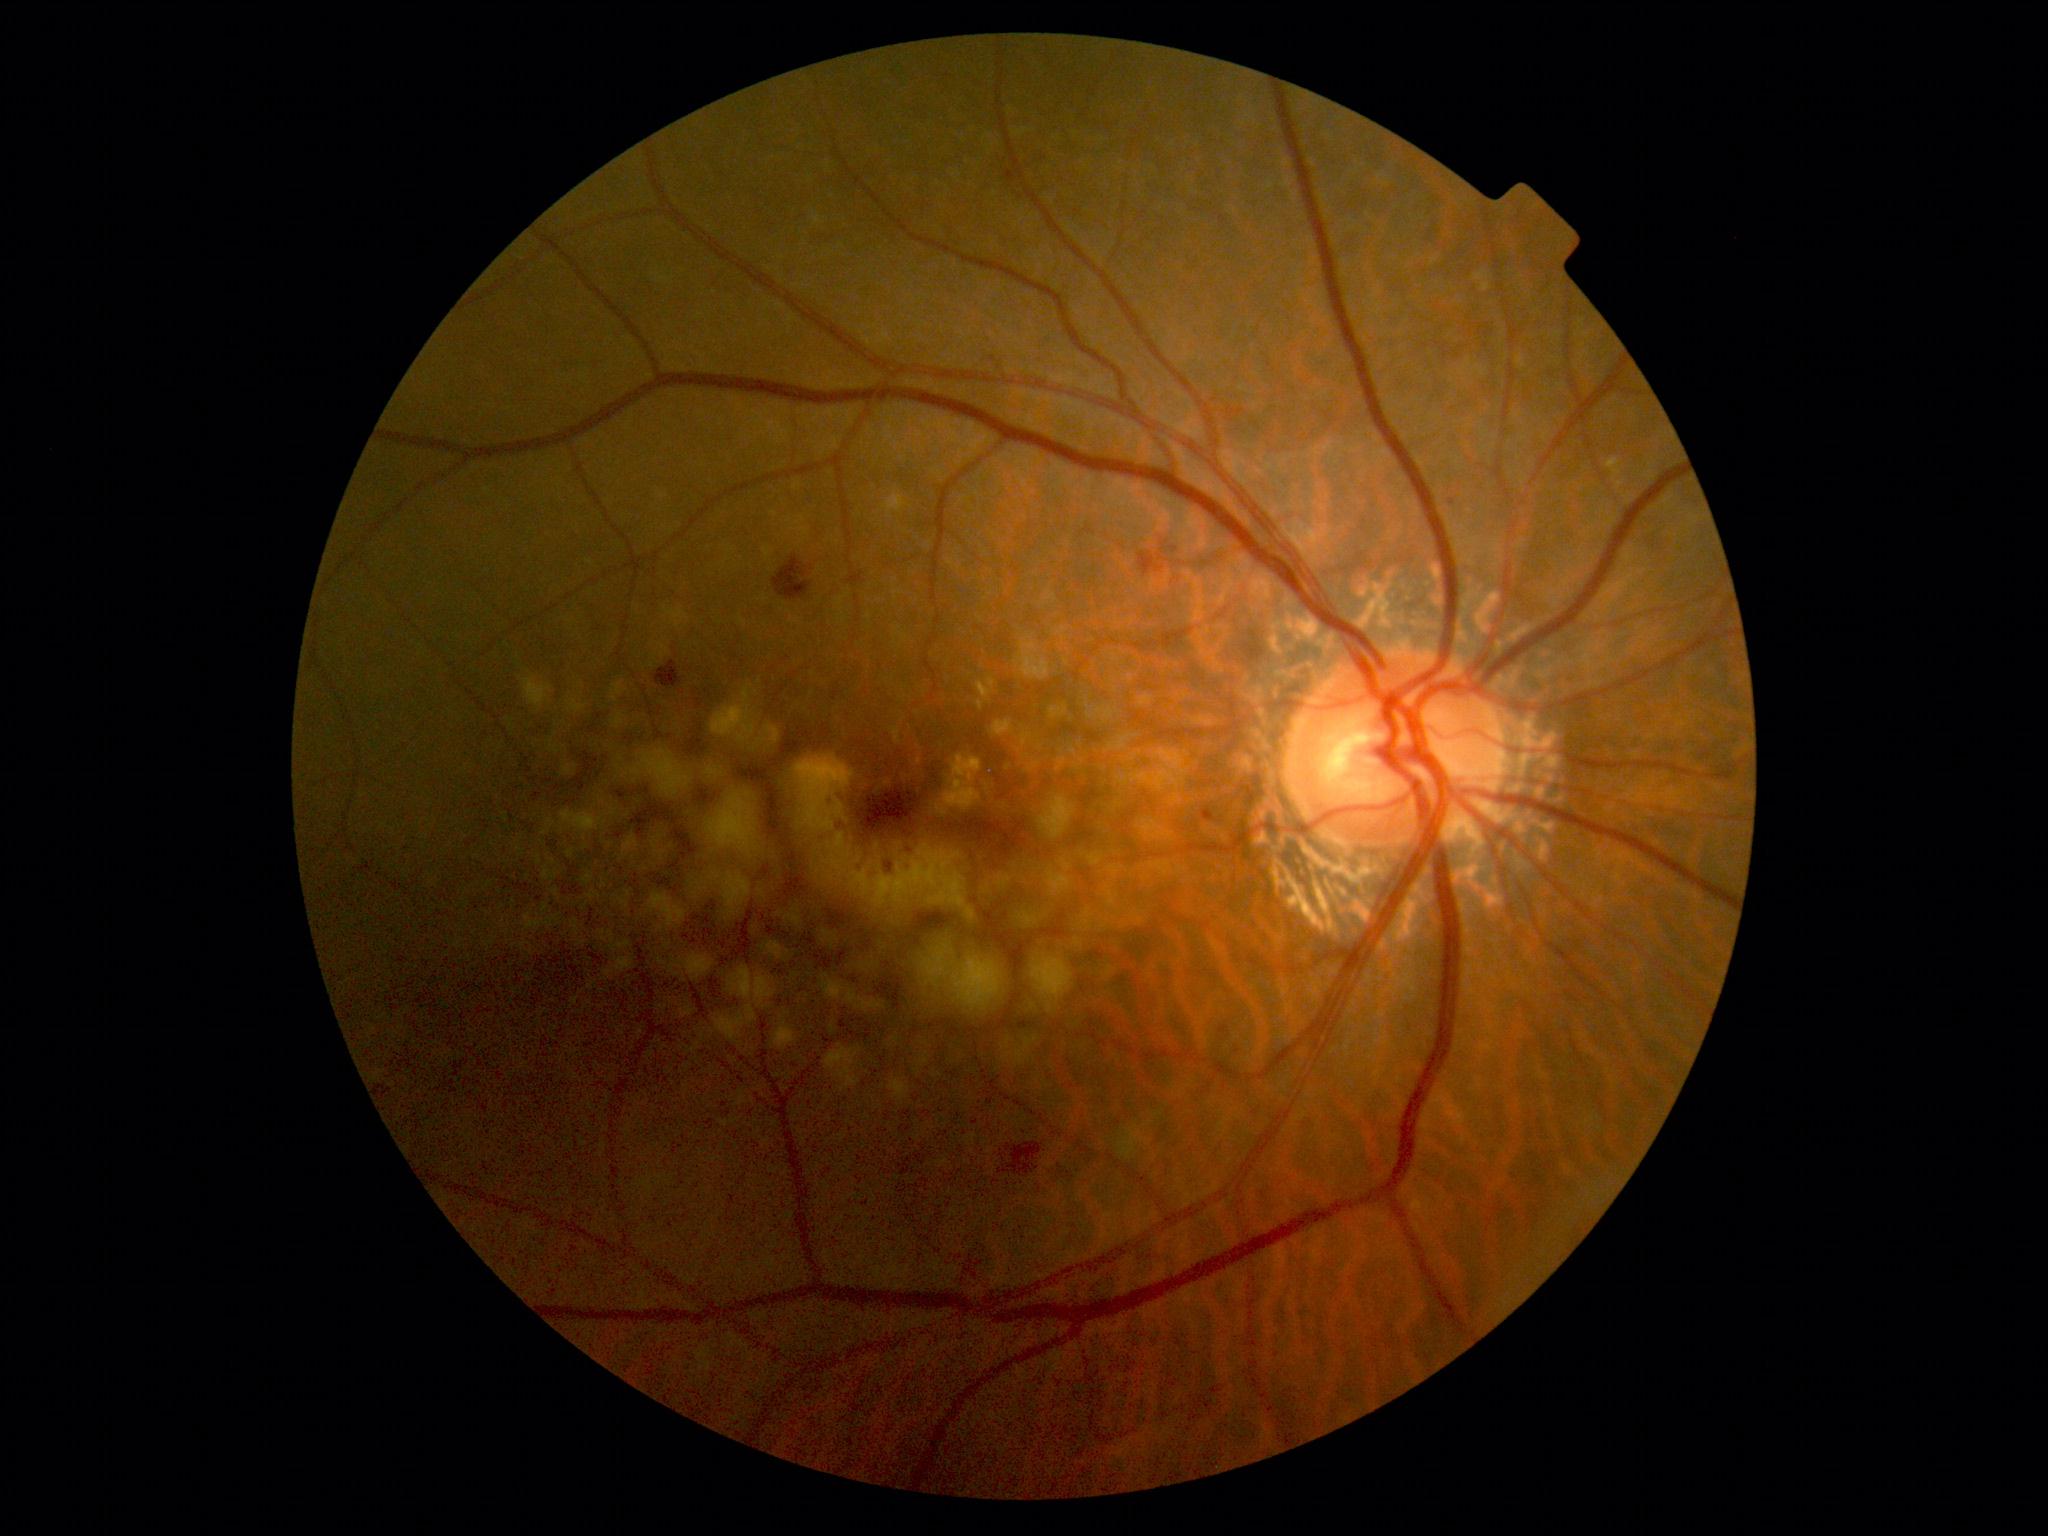

Diabetic retinopathy (DR): grade 2 (moderate NPDR).